Color fundus photograph.
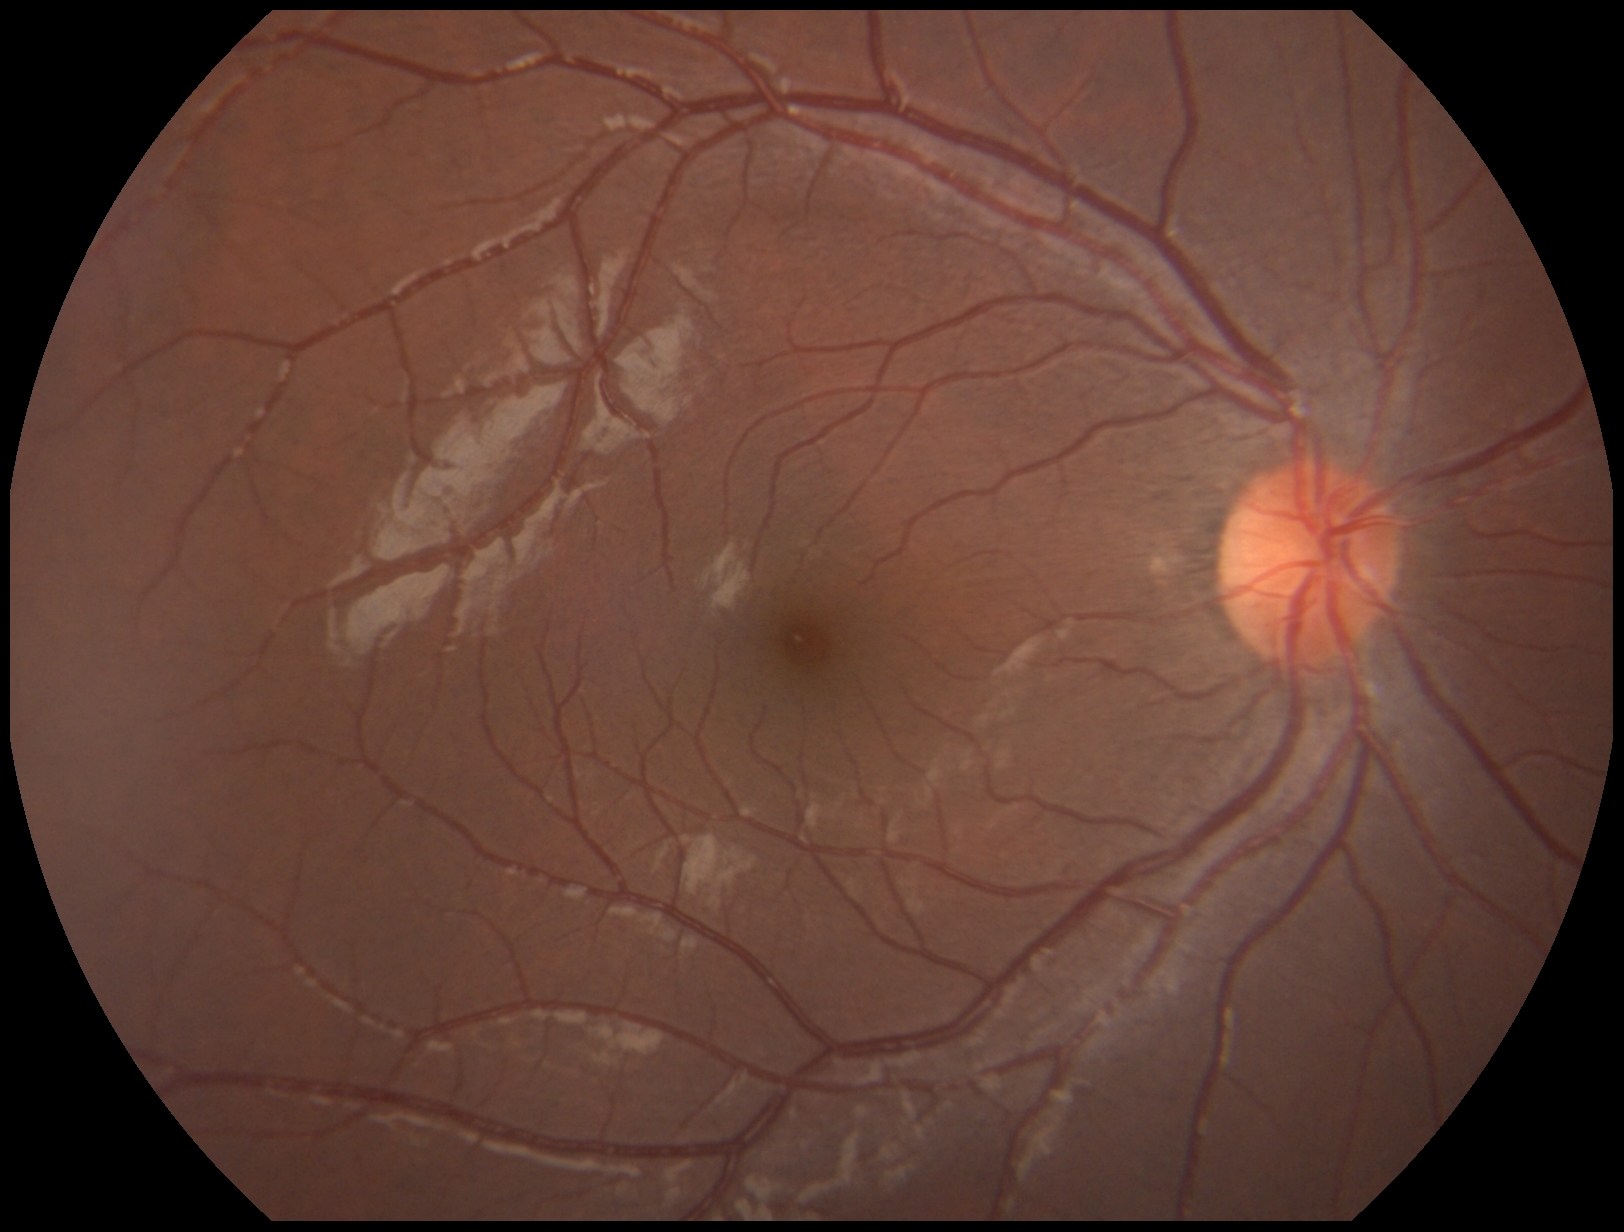

Diabetic retinopathy grade: 0 (no apparent retinopathy).